2352 x 1568 pixels:
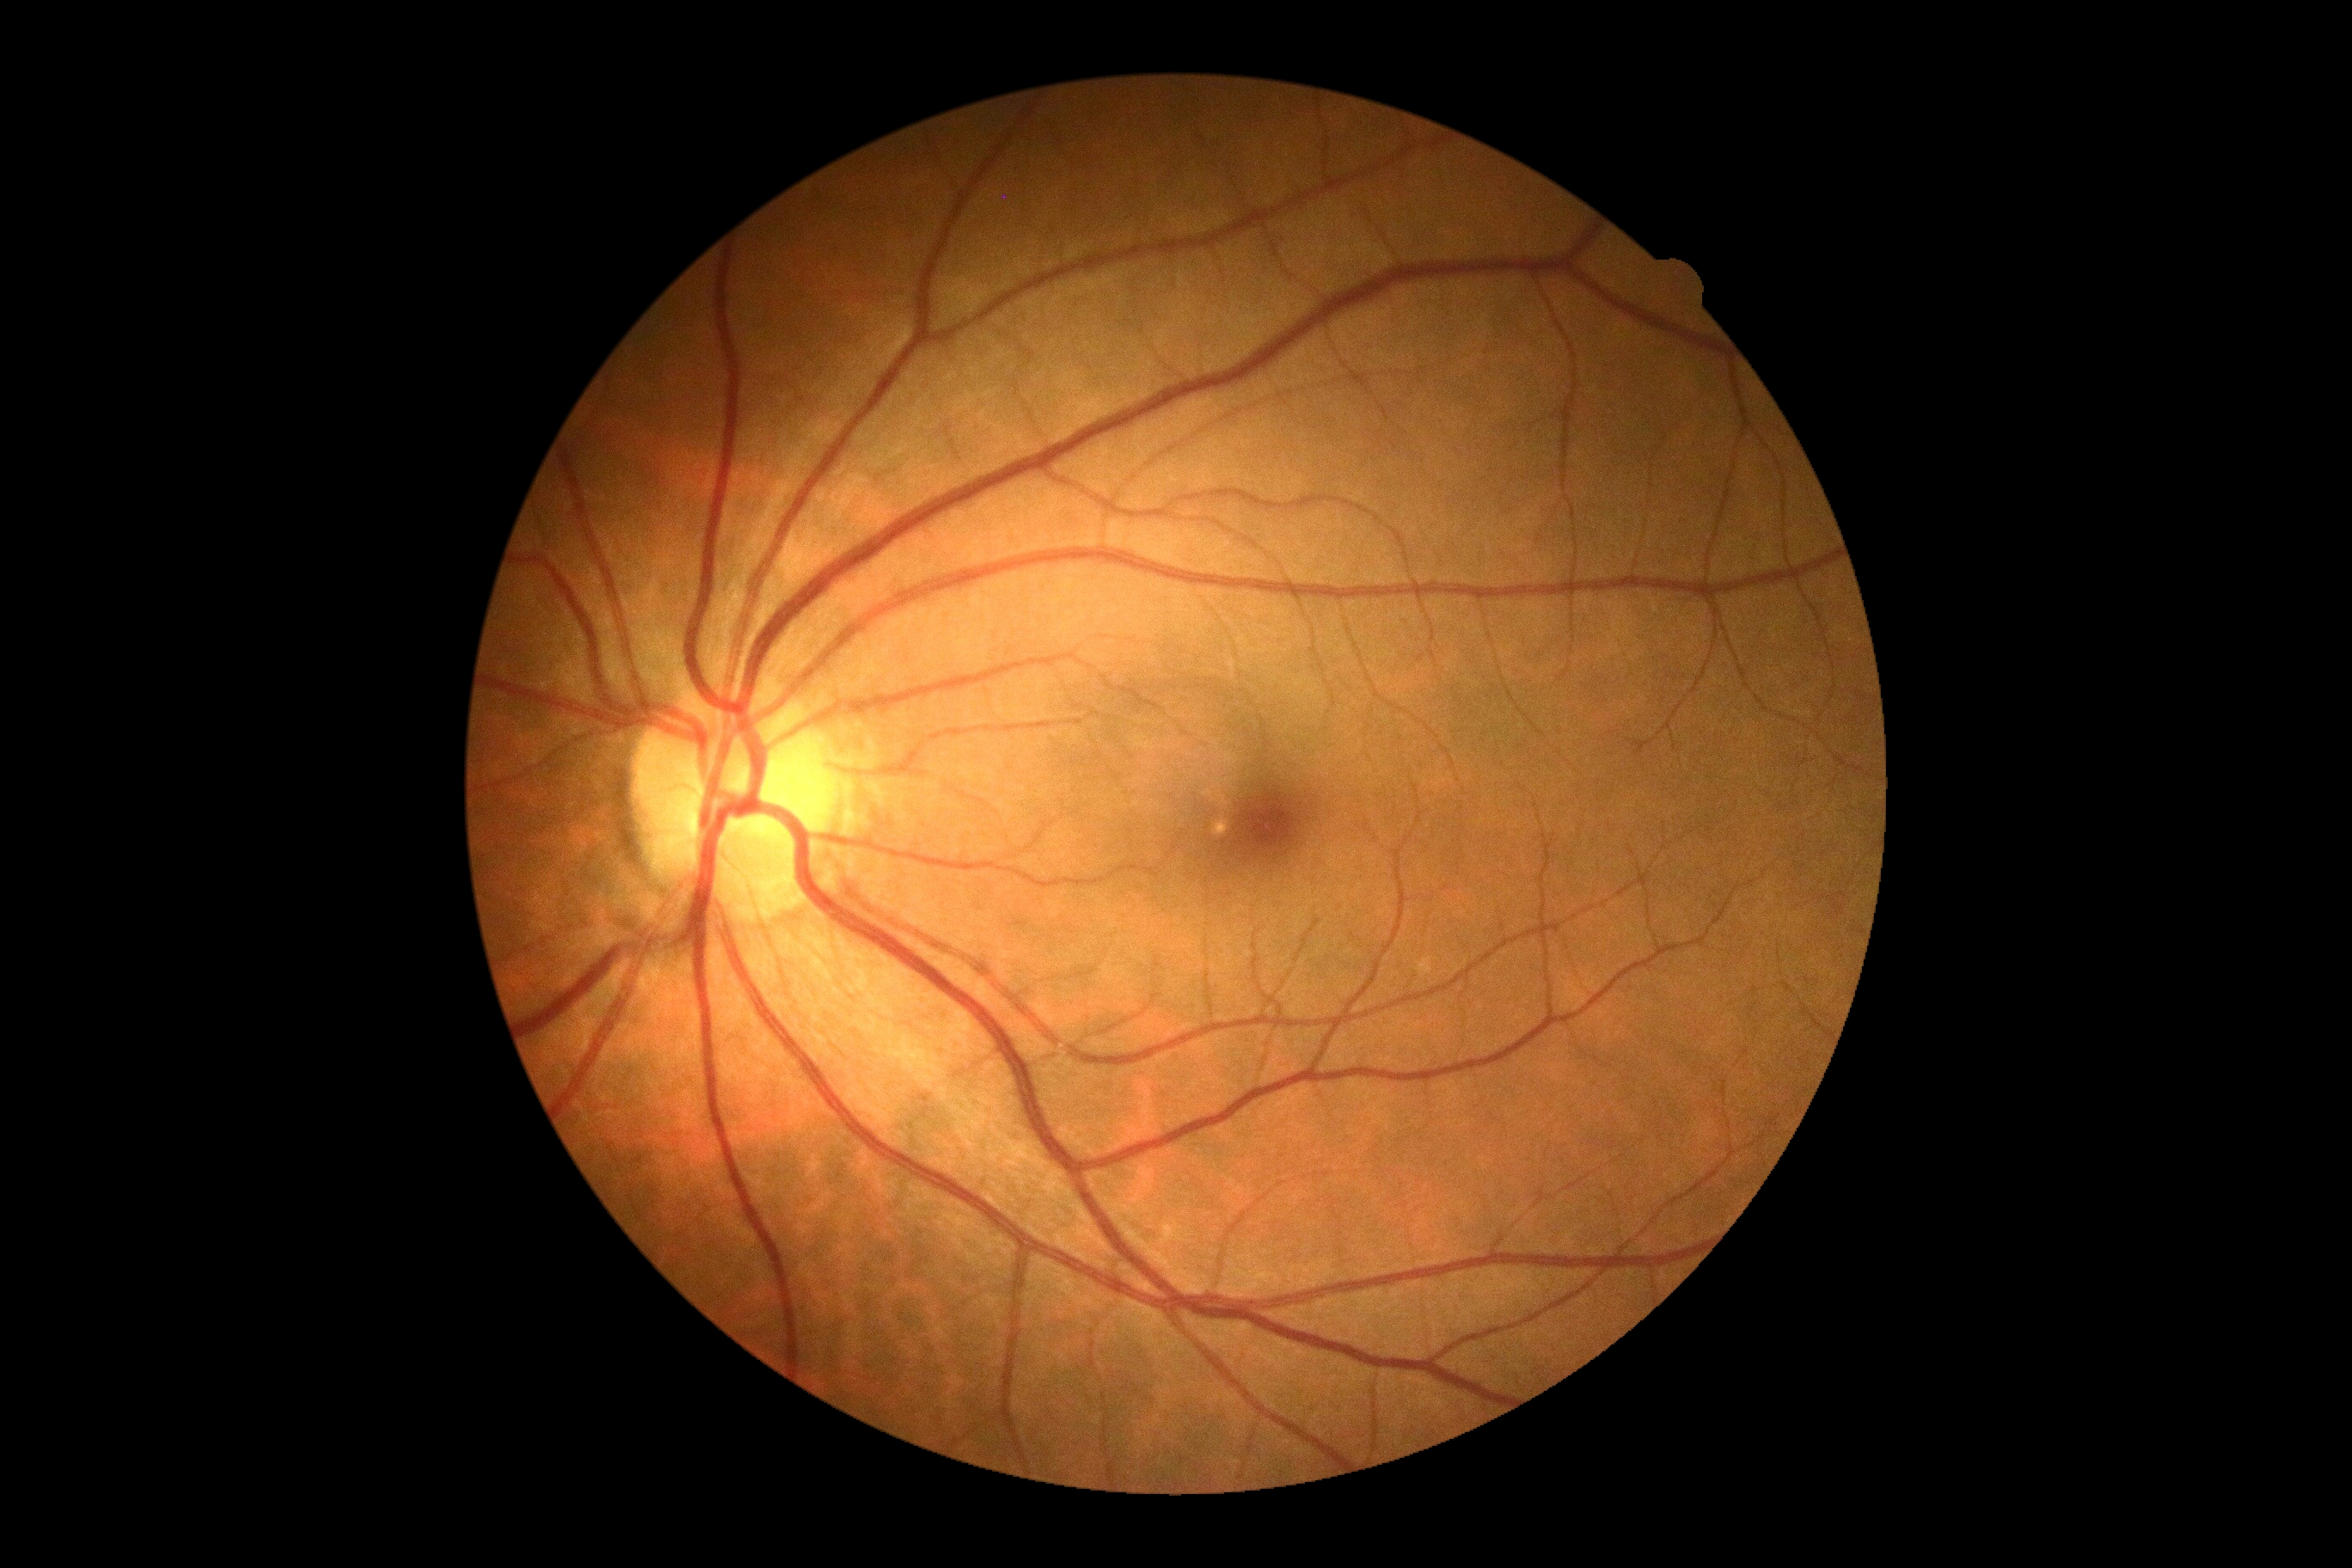
Diabetic retinopathy severity: no apparent retinopathy (grade 0).